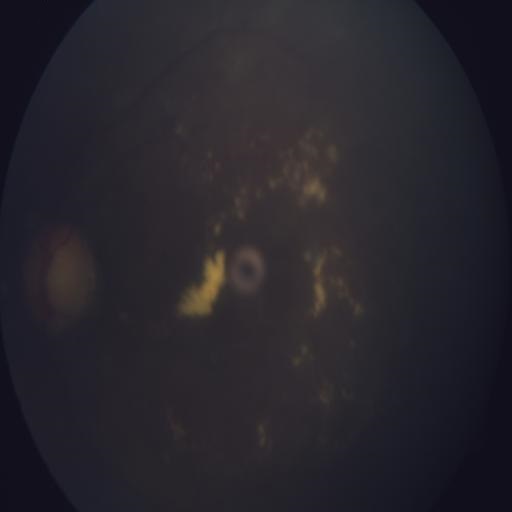

Impression: cotton wool spots.